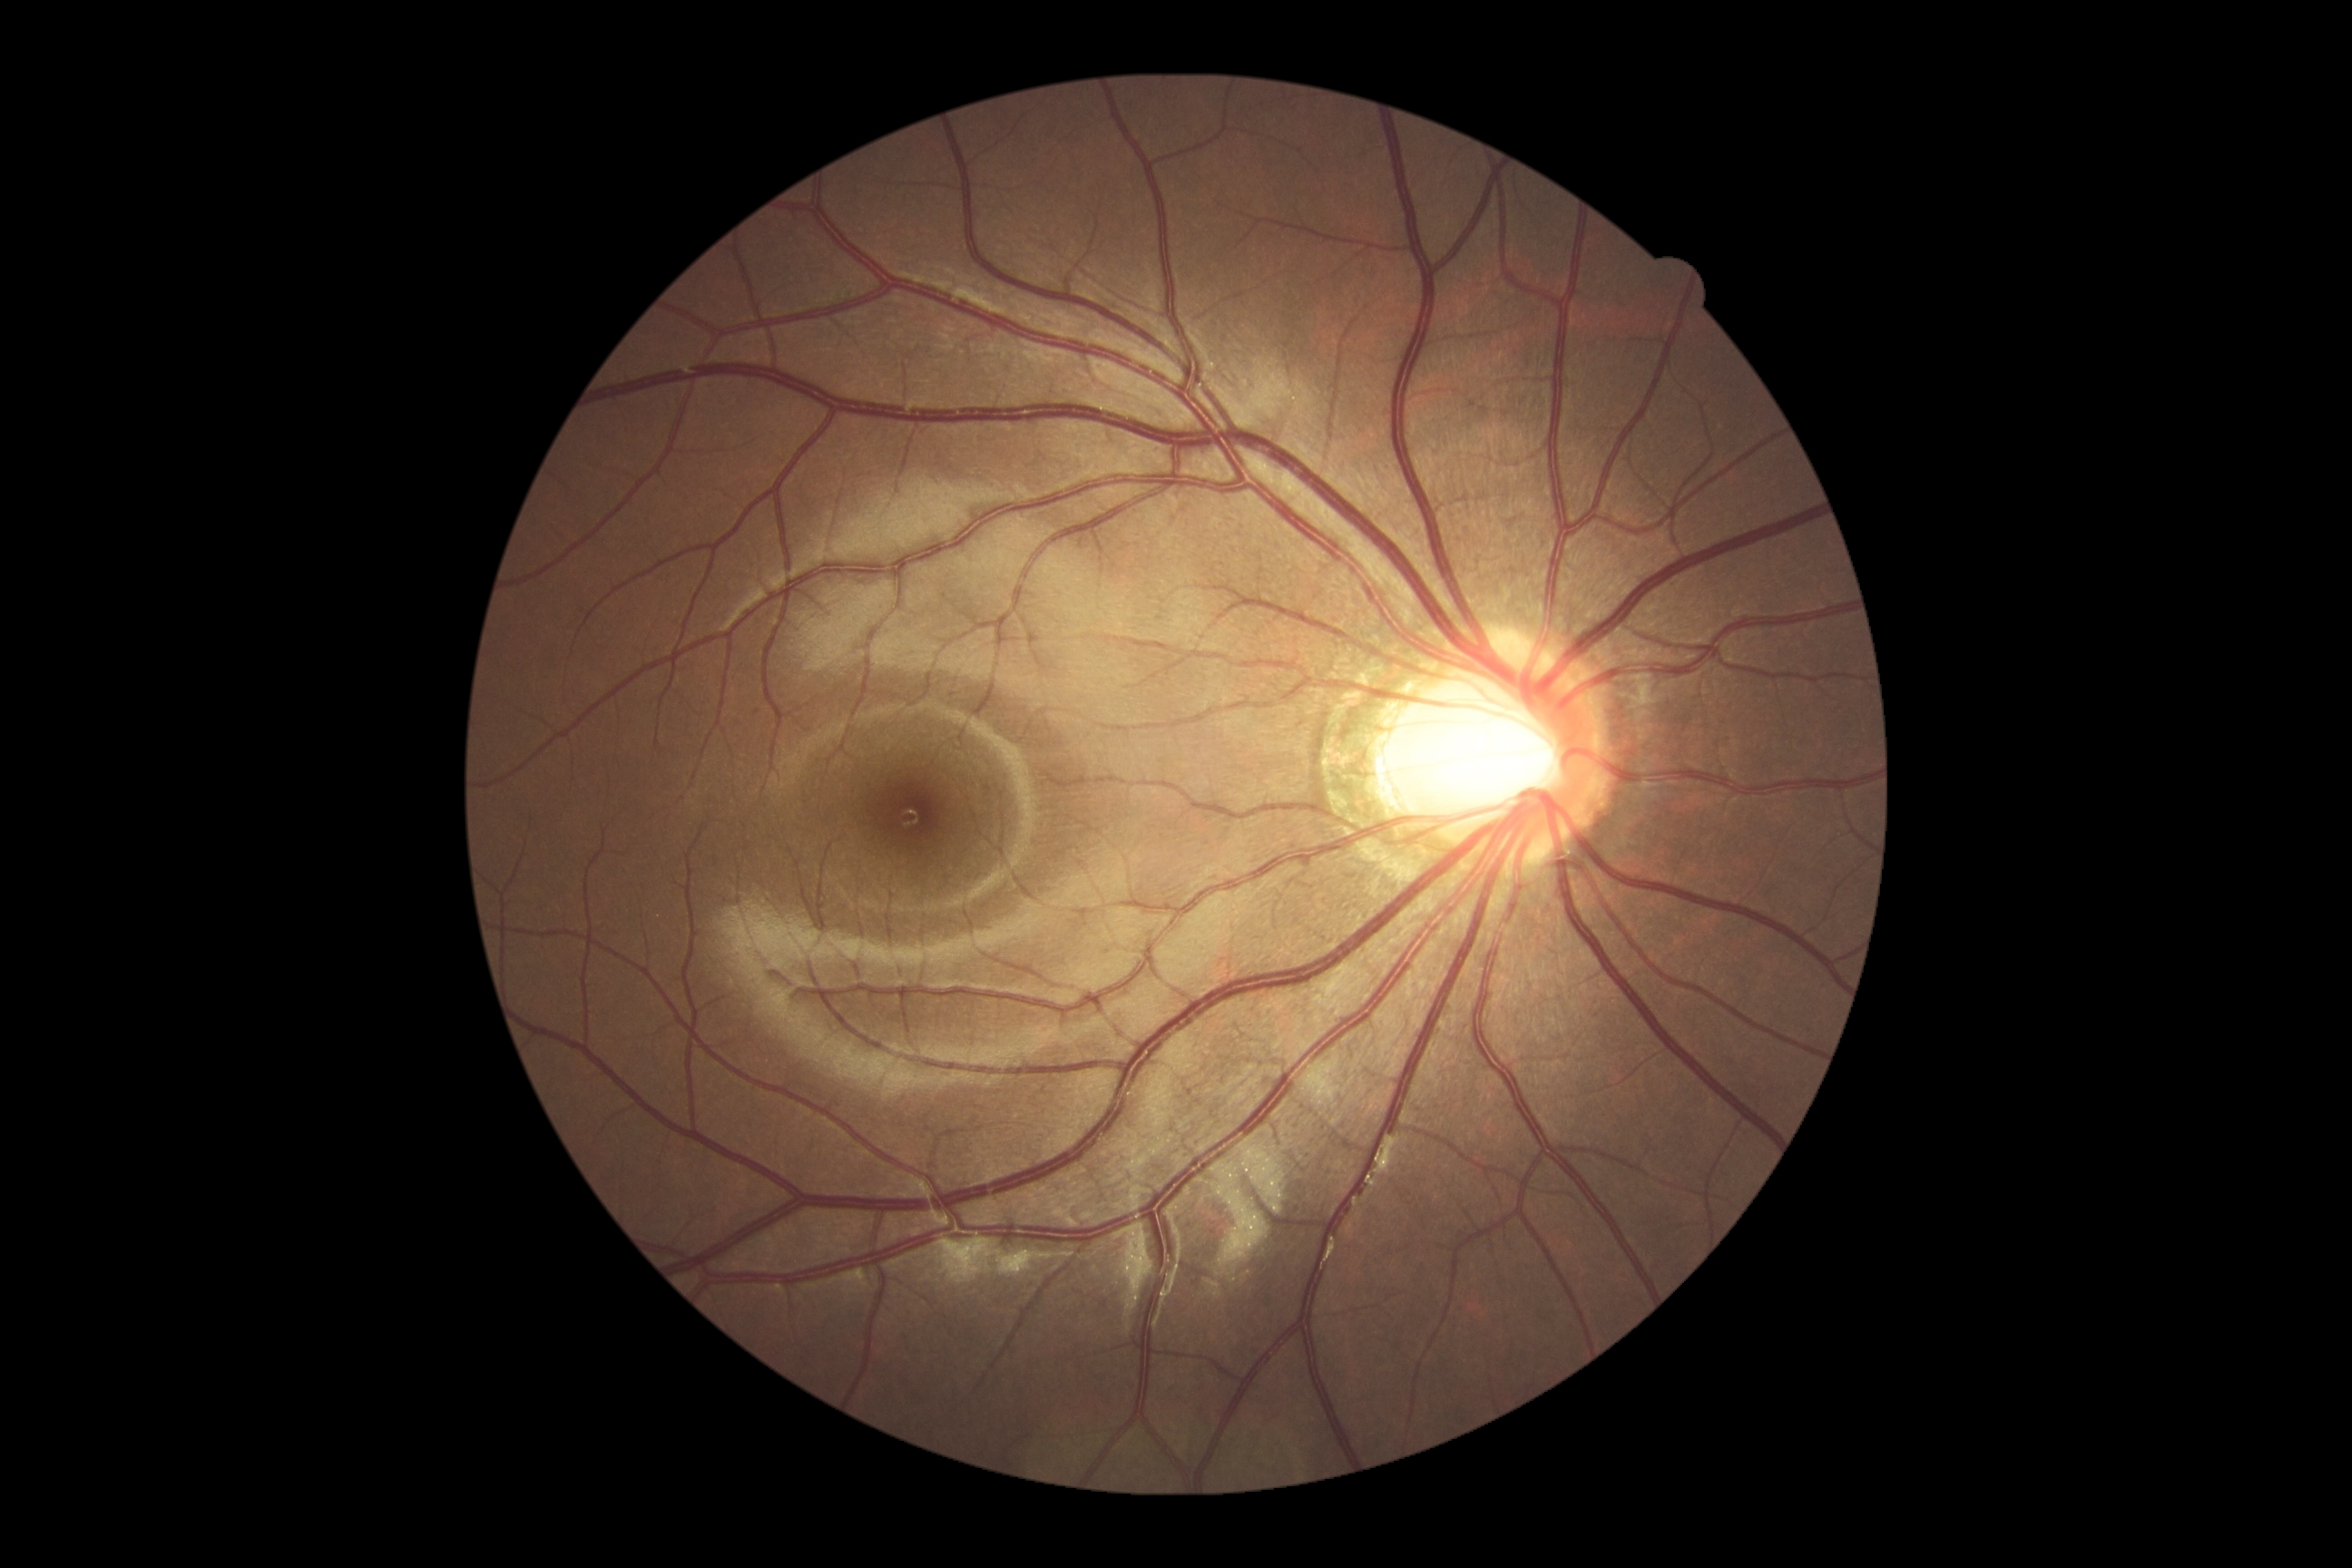
DR grade = 0 (no apparent retinopathy).